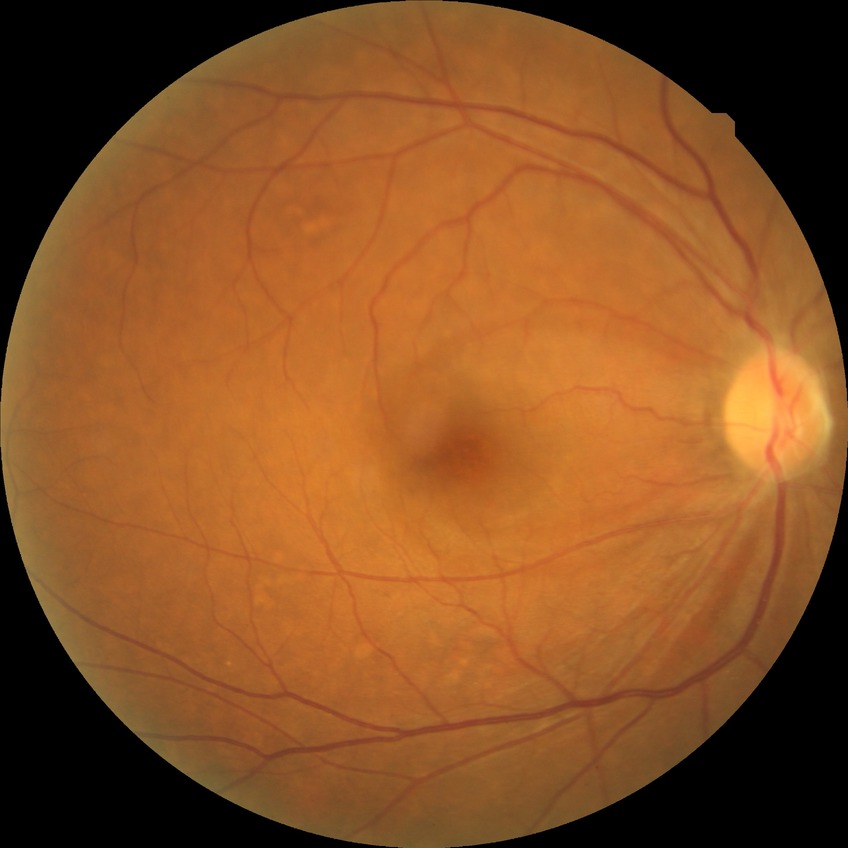 Diabetic retinopathy severity: no diabetic retinopathy.